45° FOV · 2212x1659px.
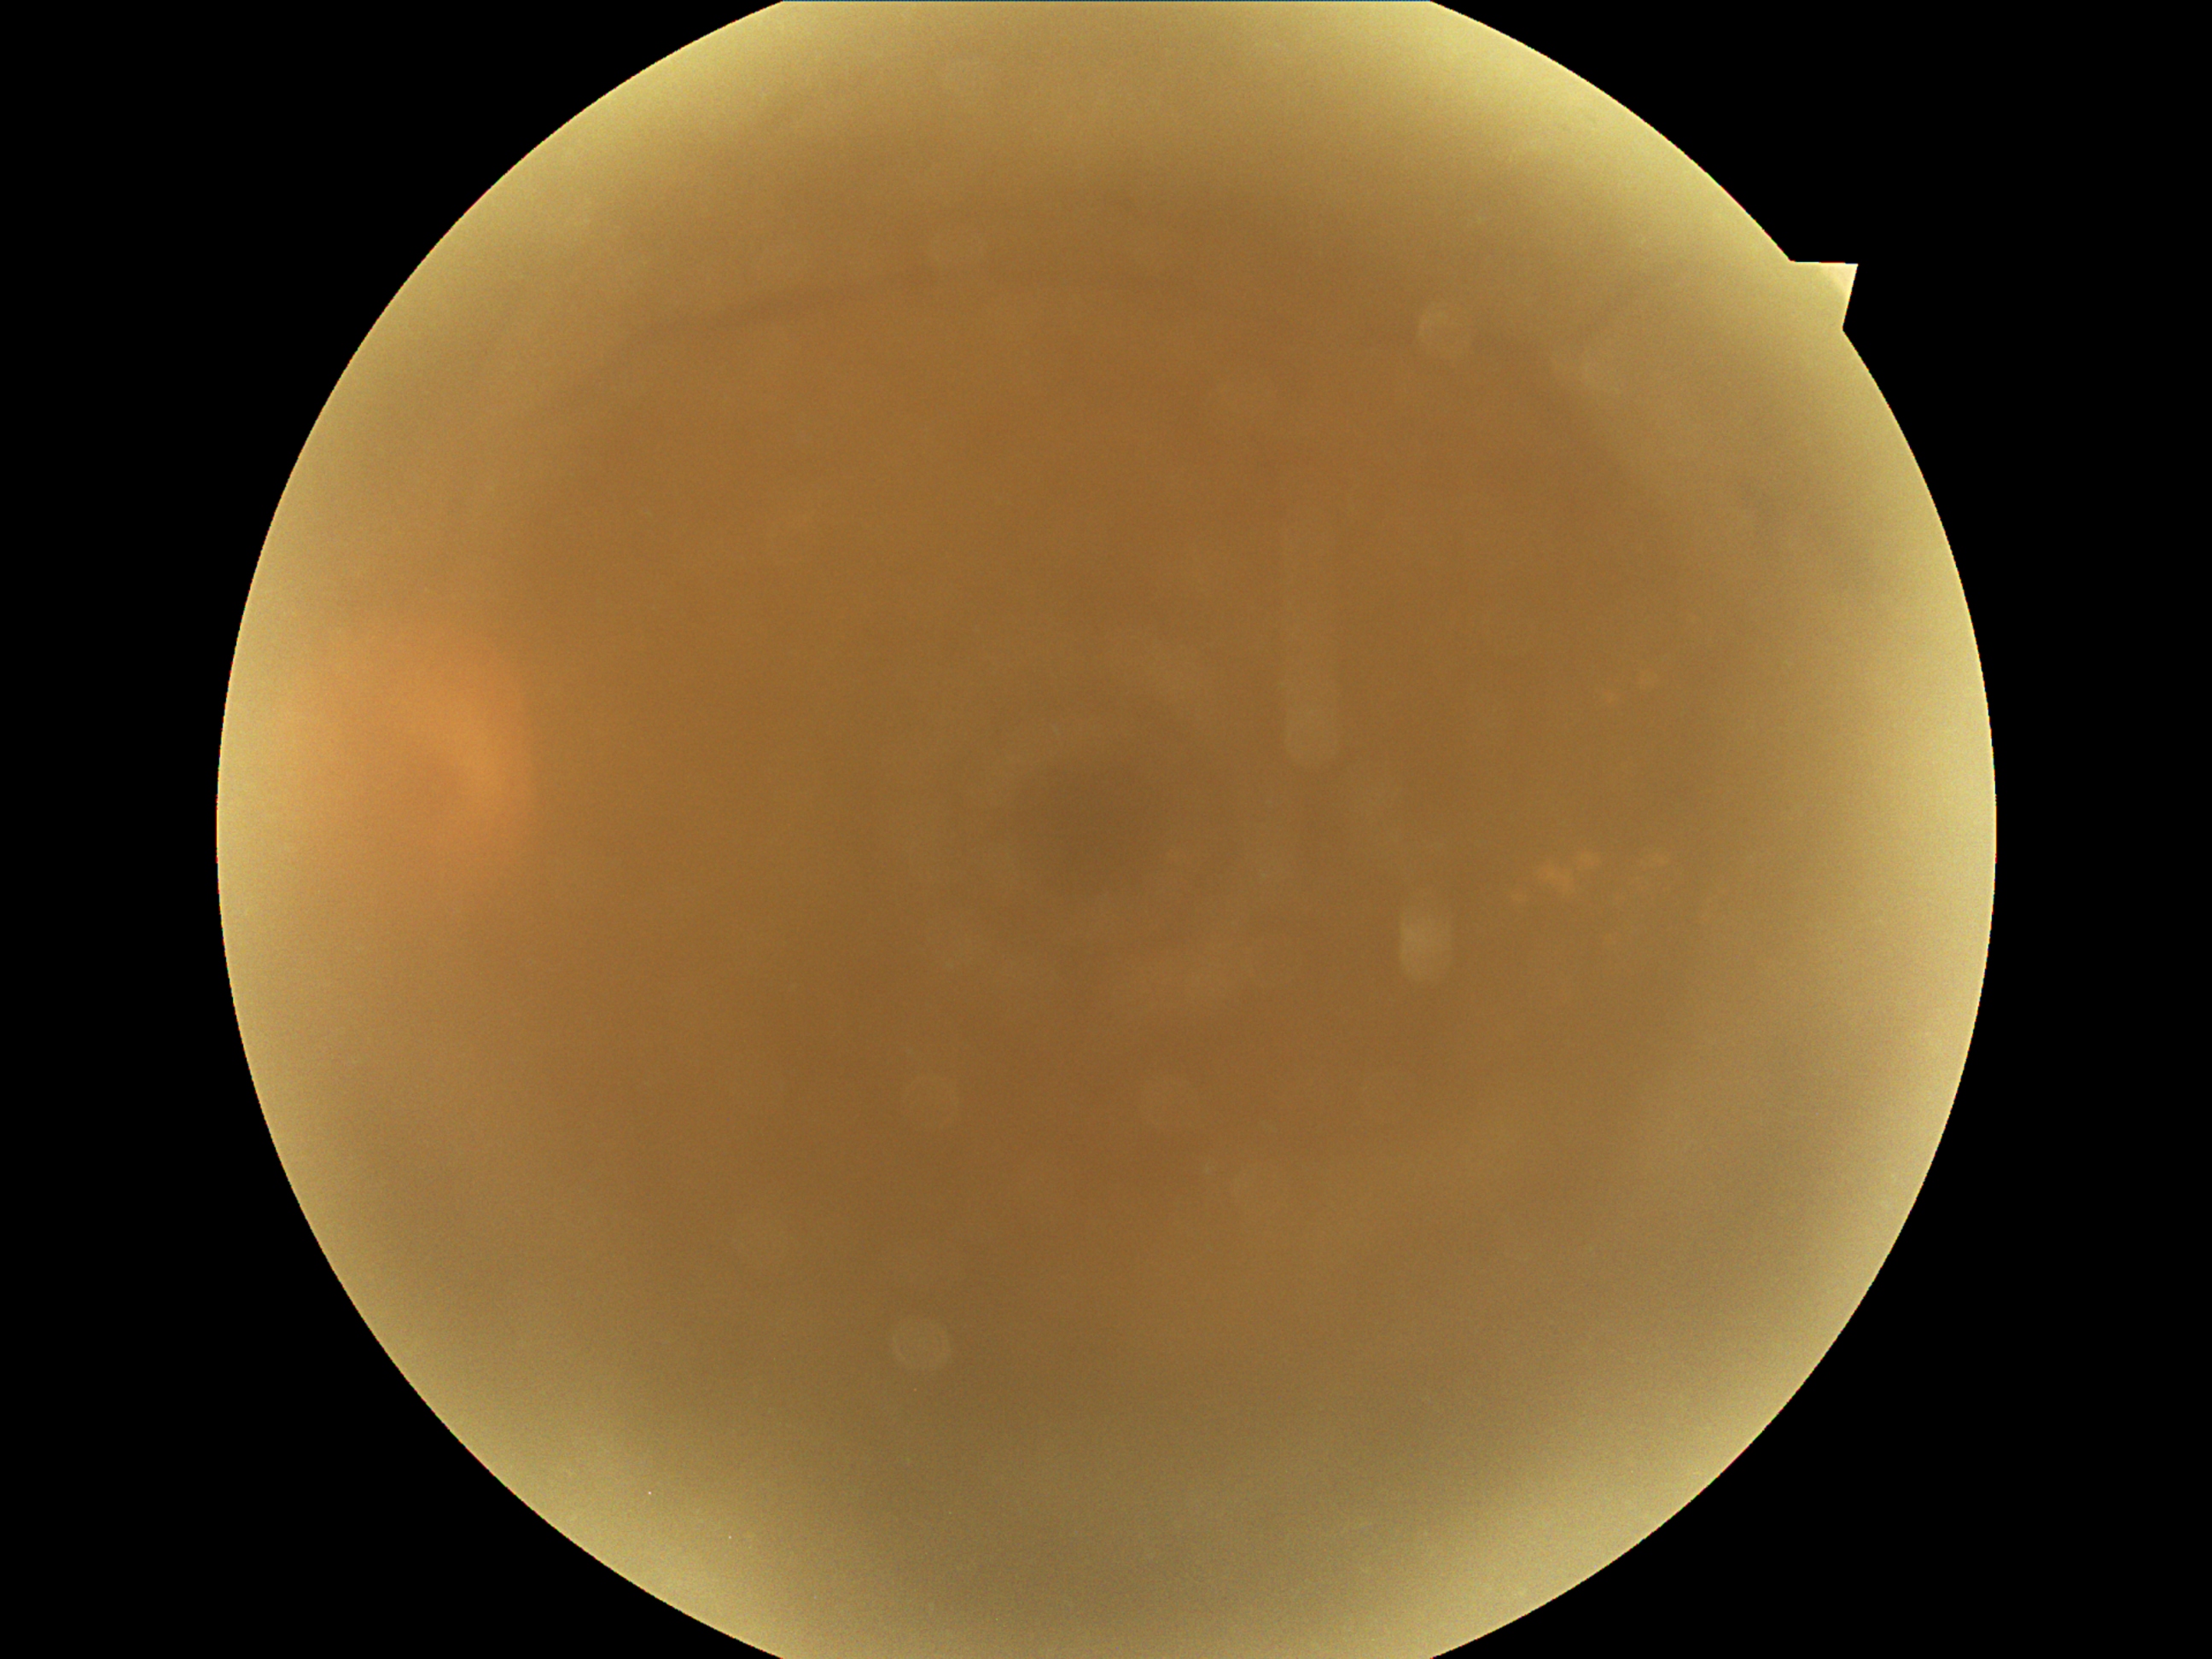

Diabetic retinopathy (DR) is ungradable. Image quality is insufficient for diabetic retinopathy assessment.